Image size 2346x1568, FOV: 45 degrees
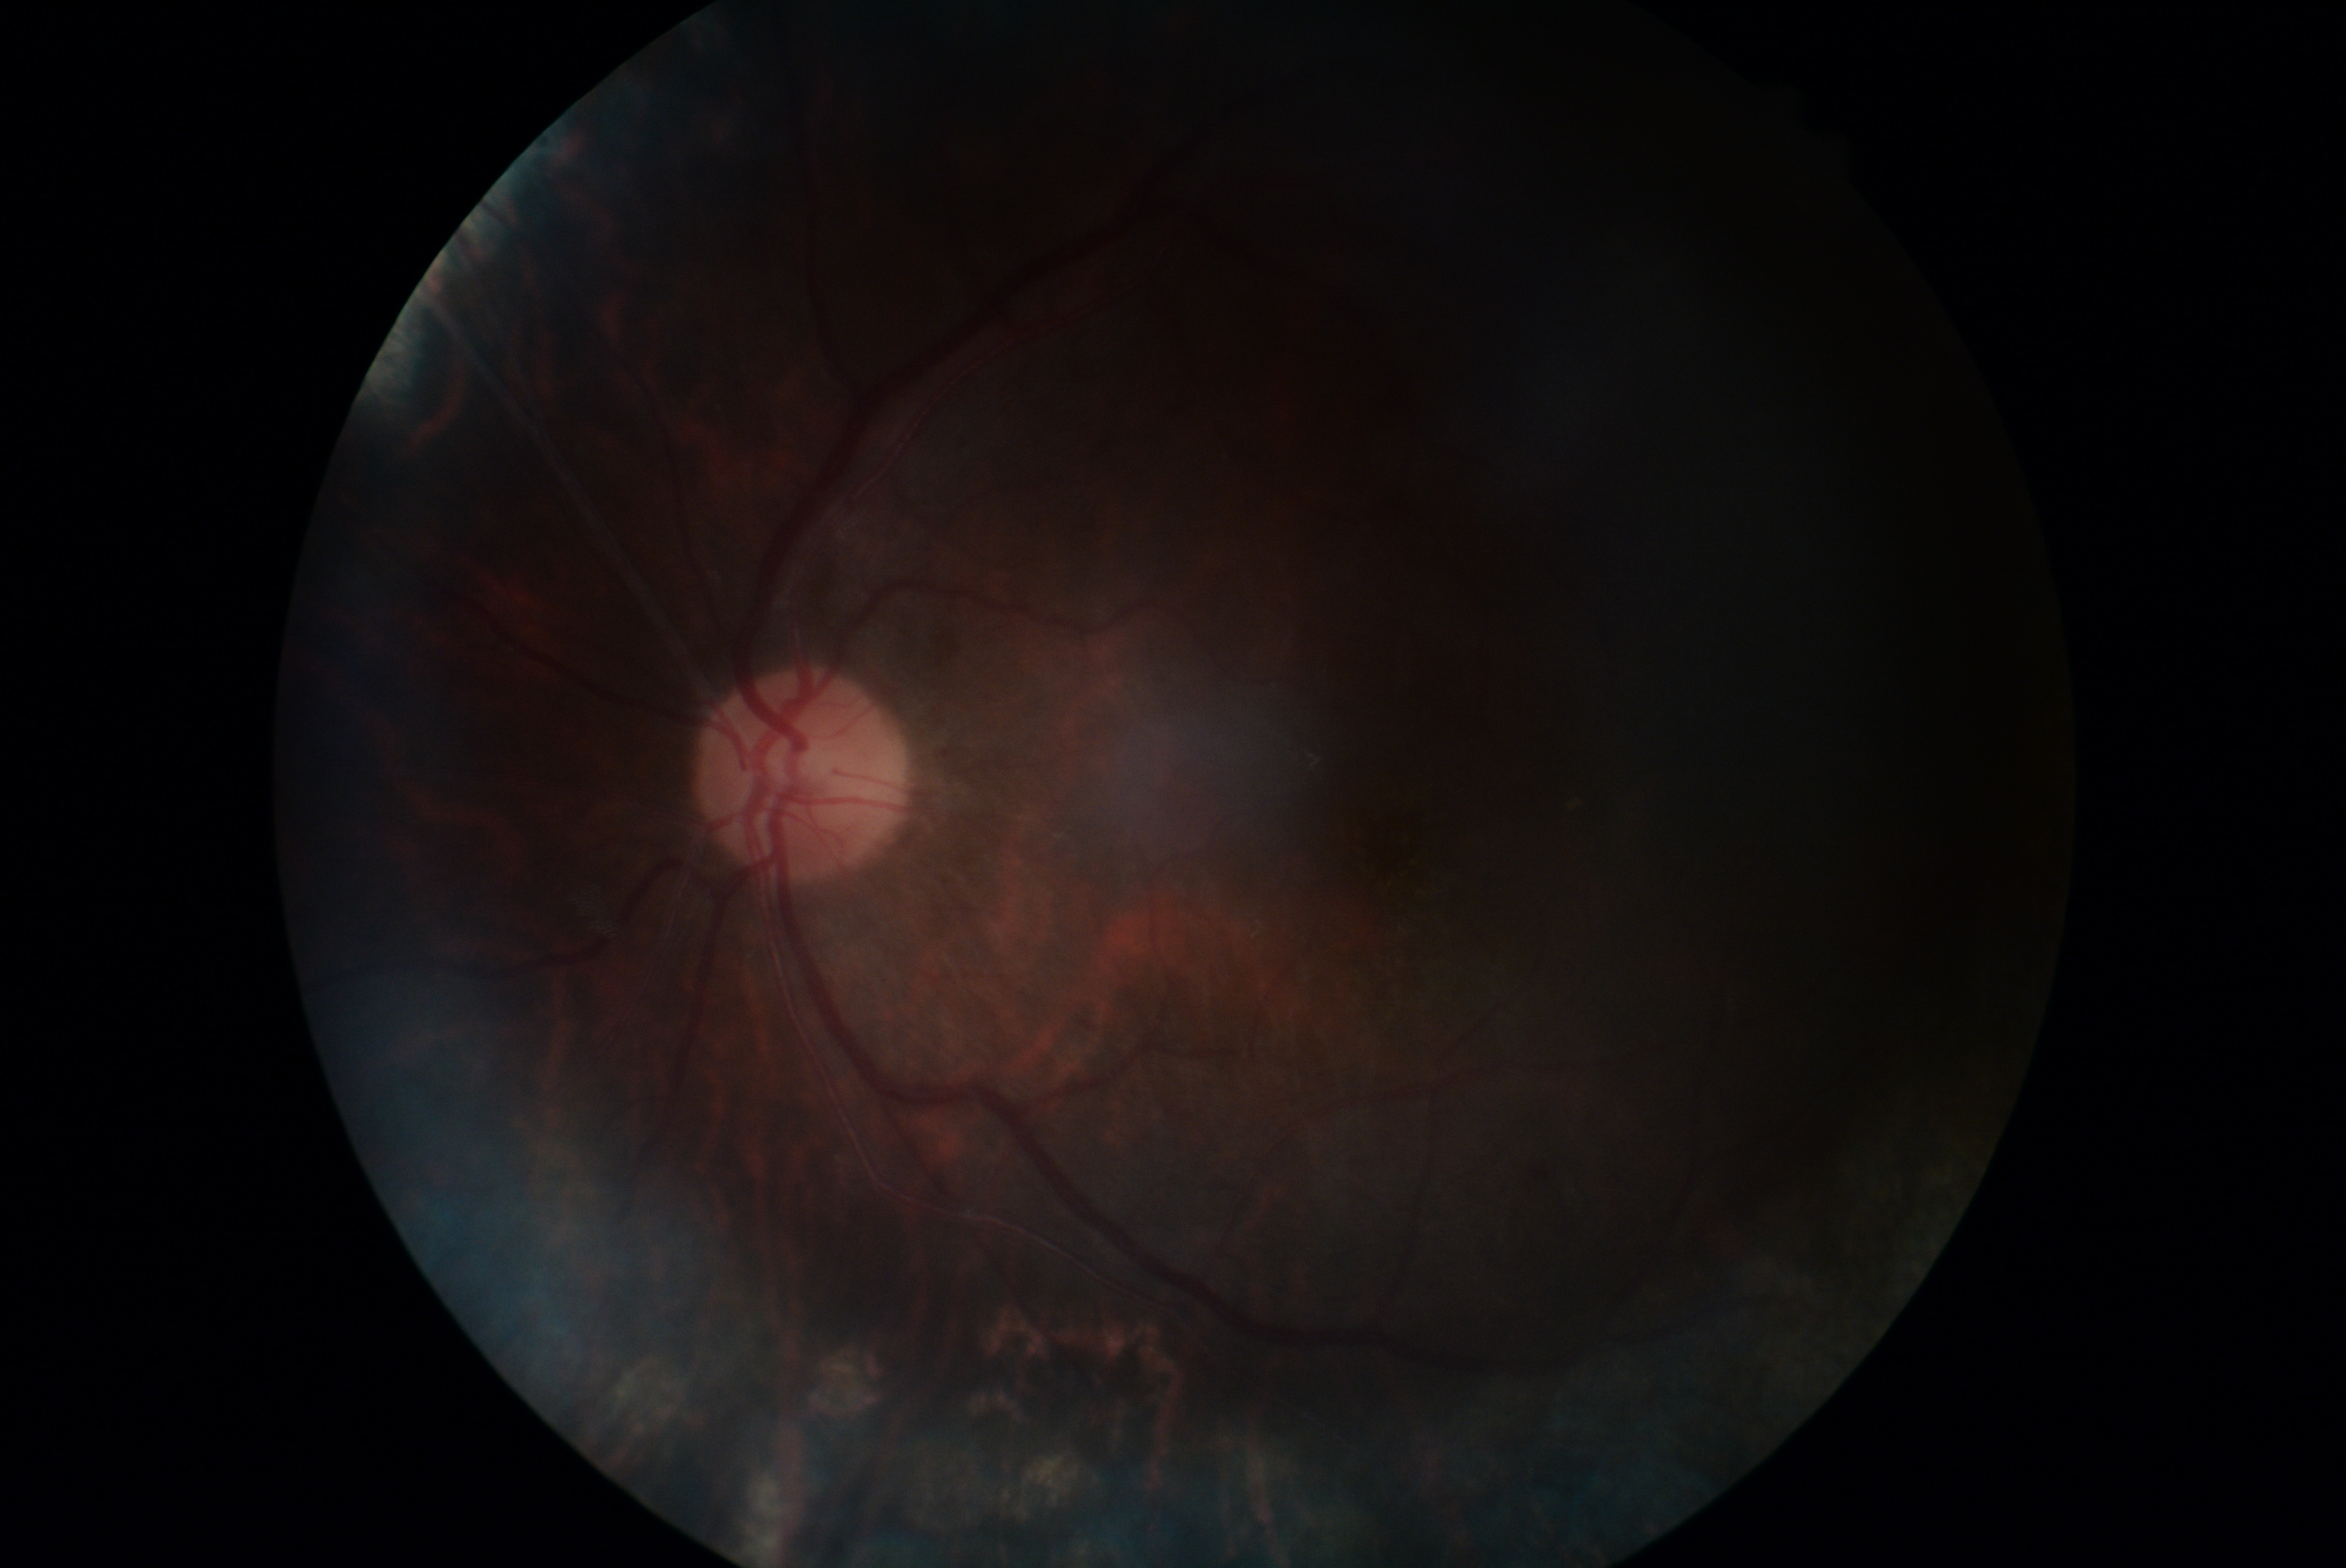
DR is ungradable.